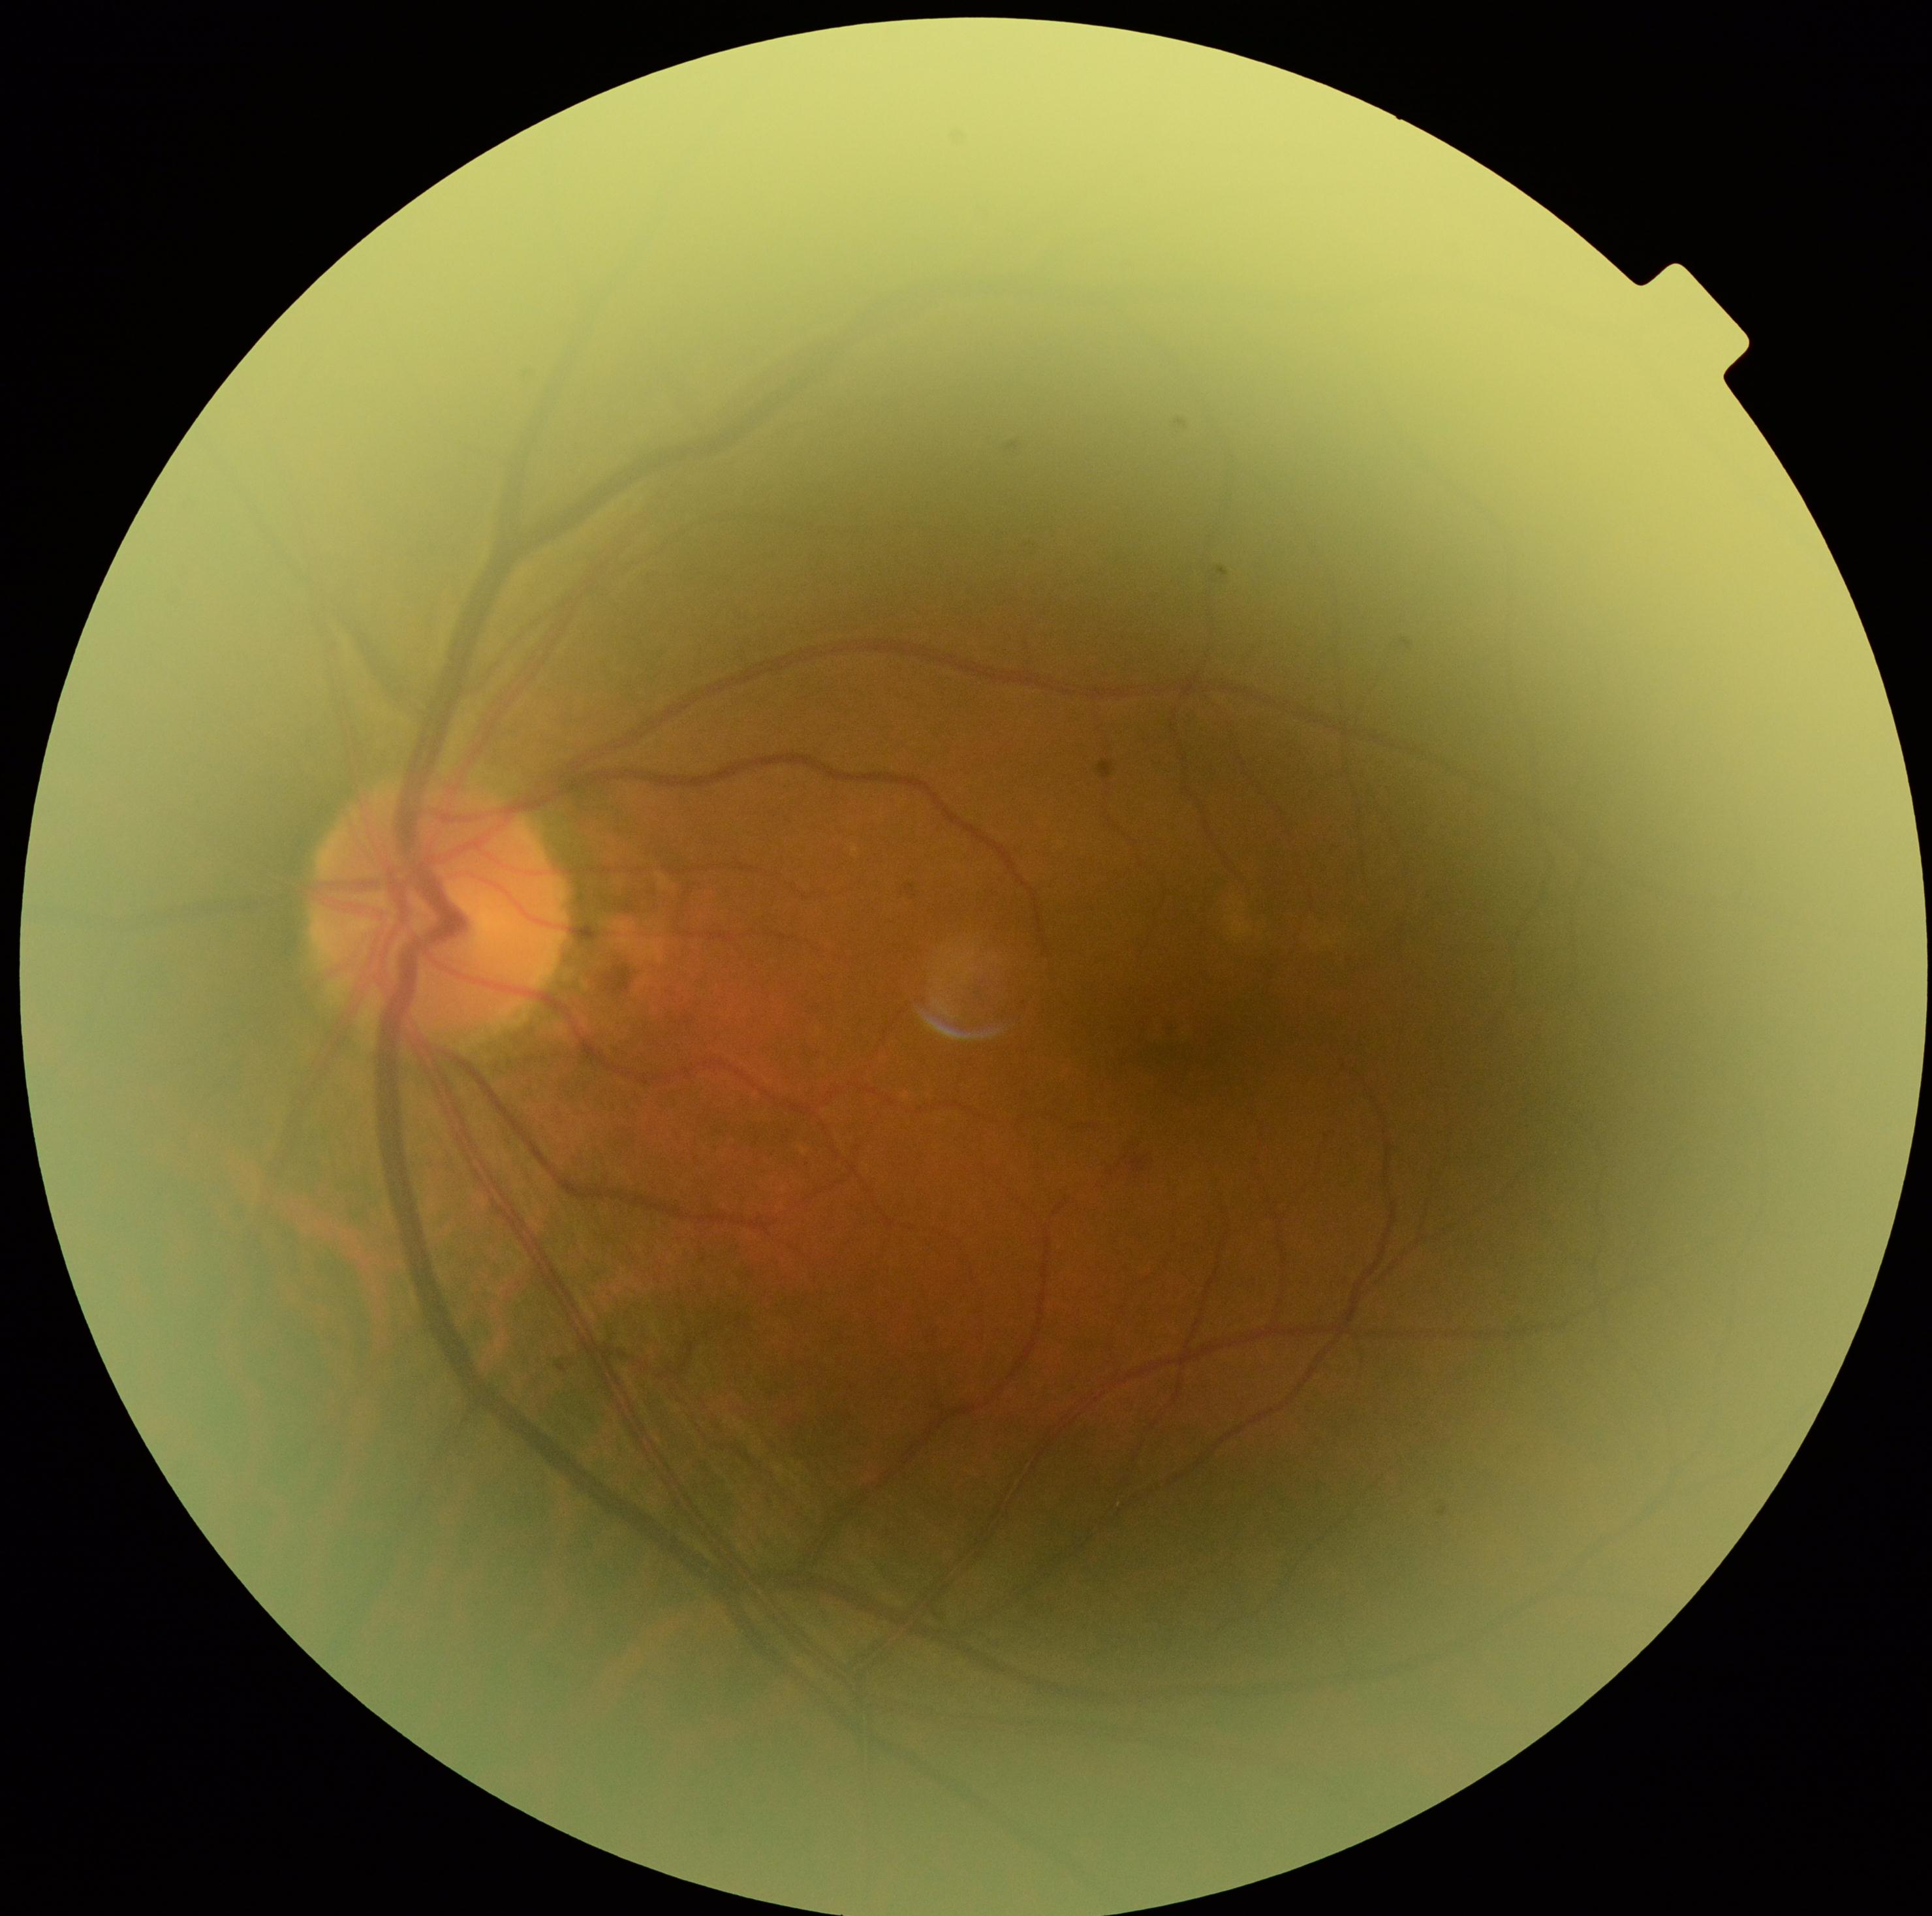
DR severity is 2/4.